Portable fundus photograph.
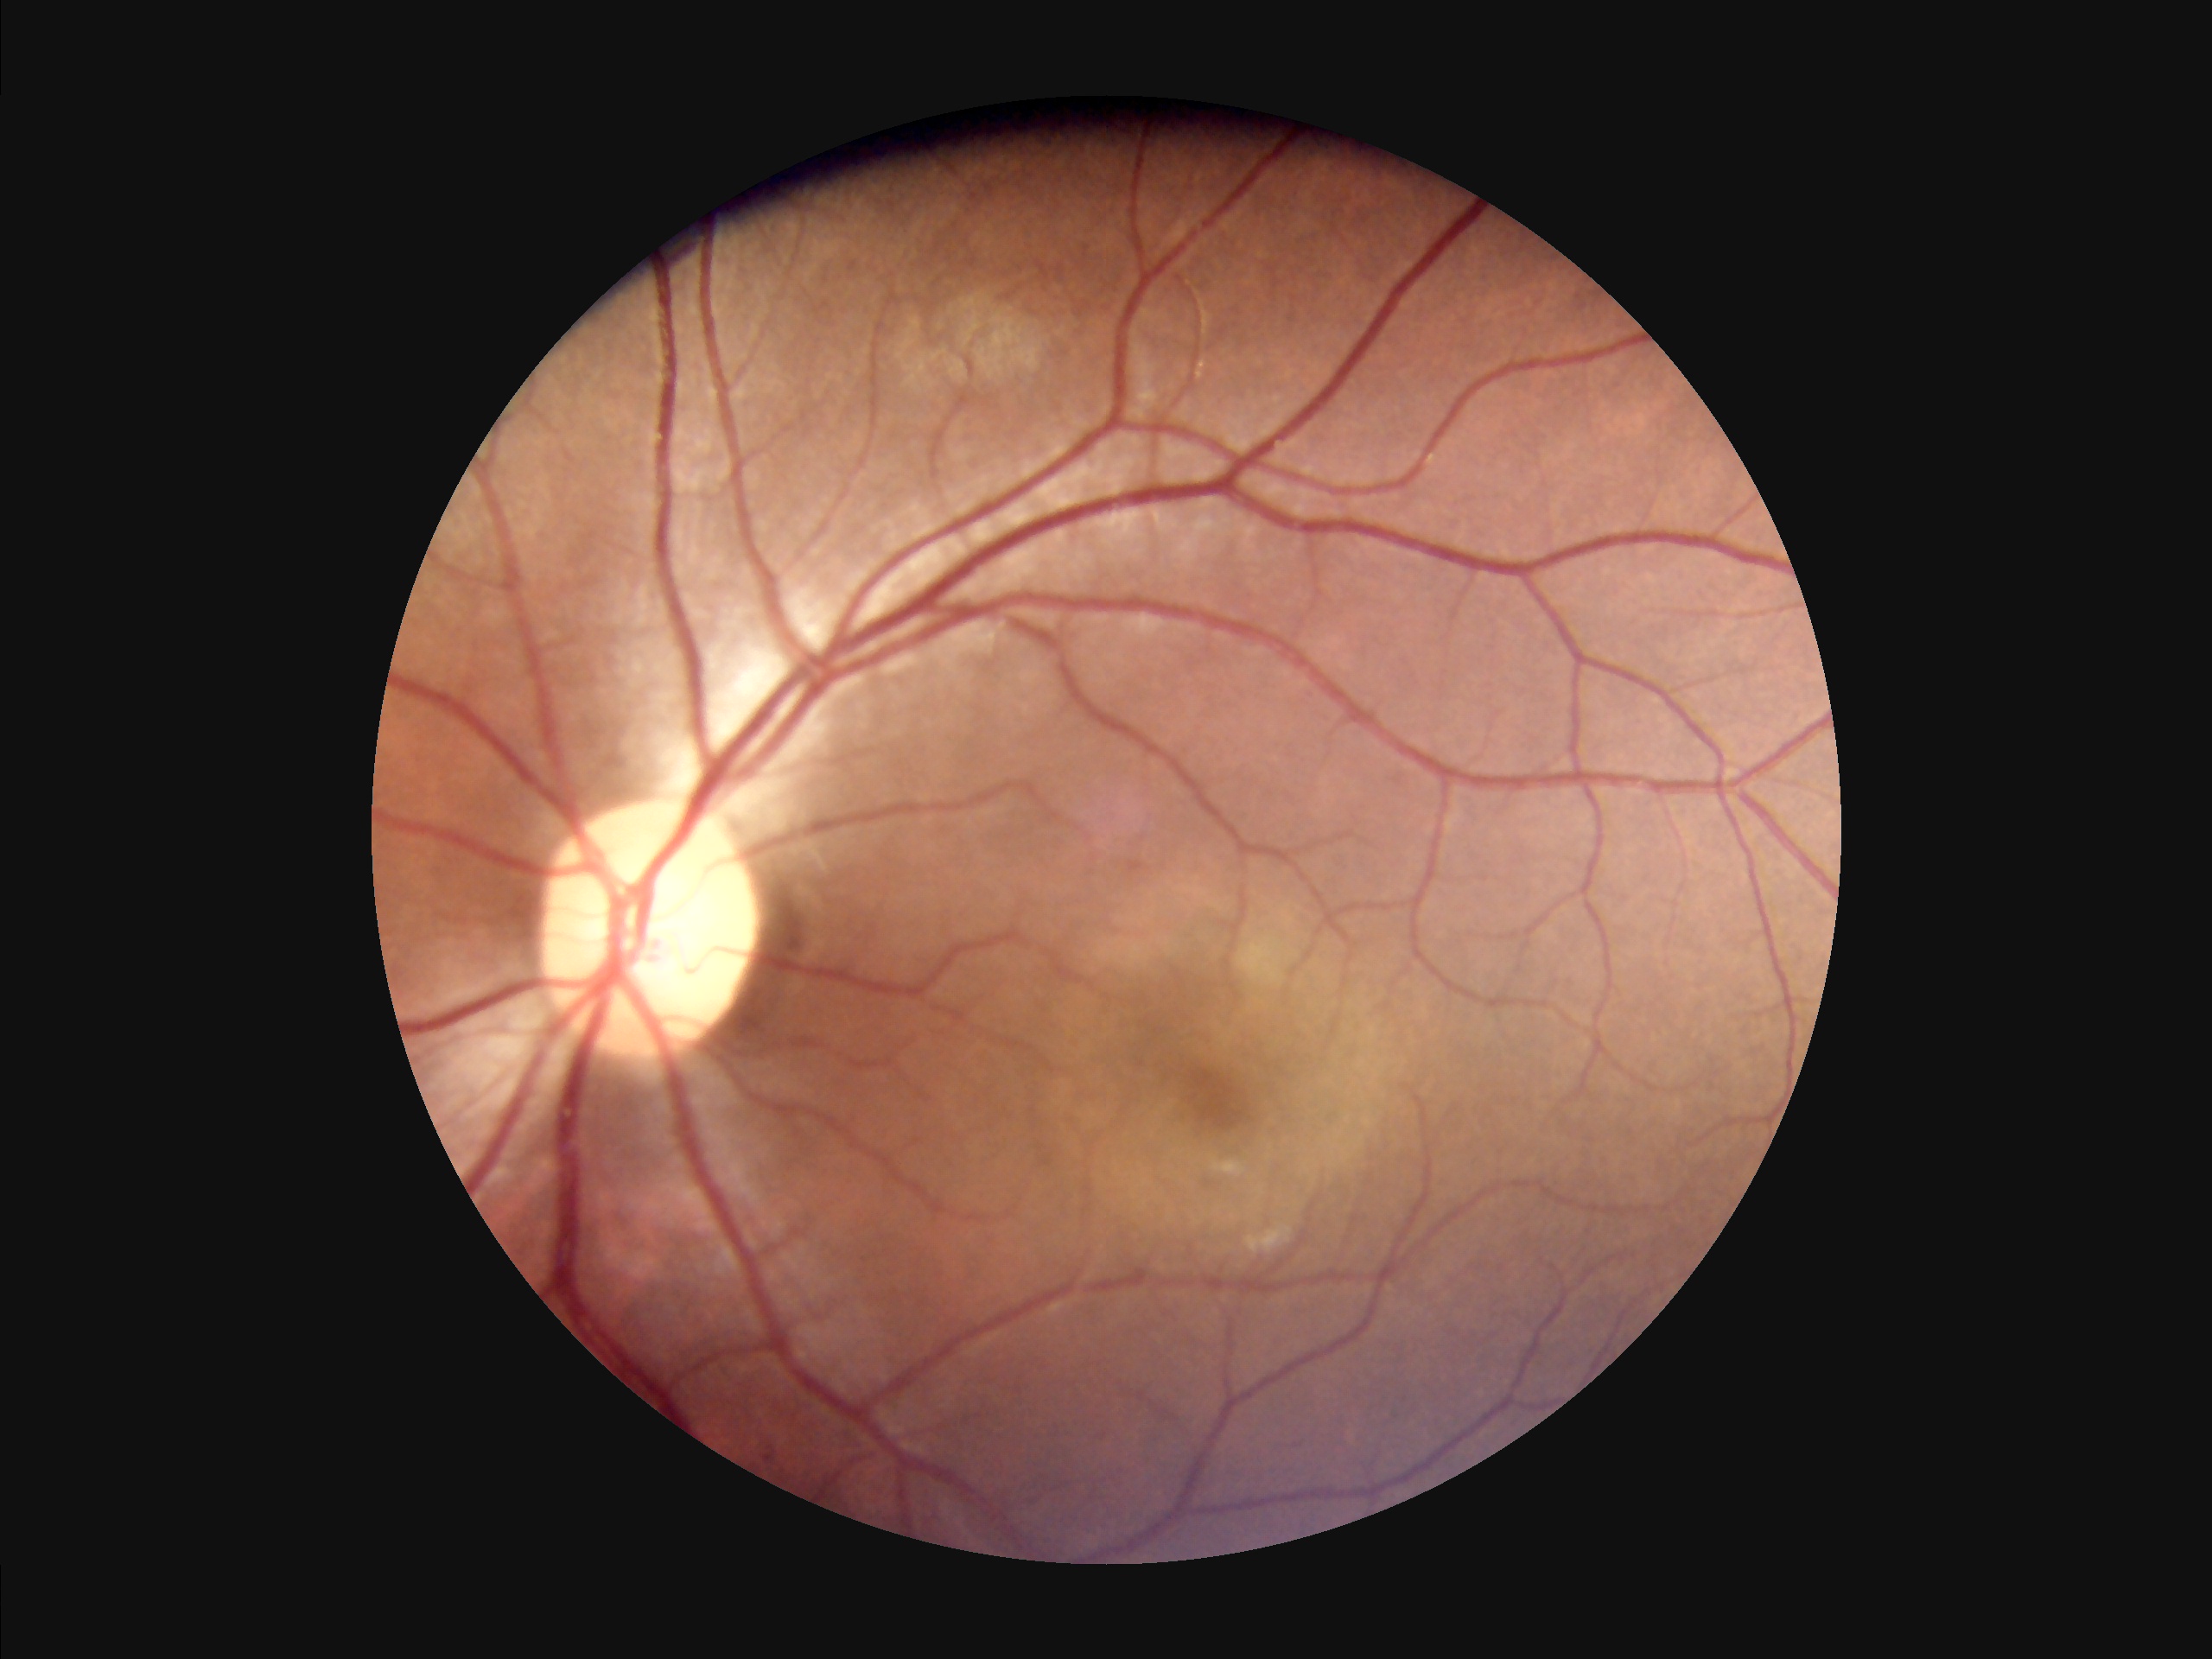
Acceptable image quality. Adequate contrast for distinguishing structures.